Camera: Nidek AFC-330. 240x240 — 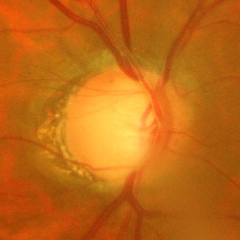
Impression = advanced glaucomatous optic neuropathy.